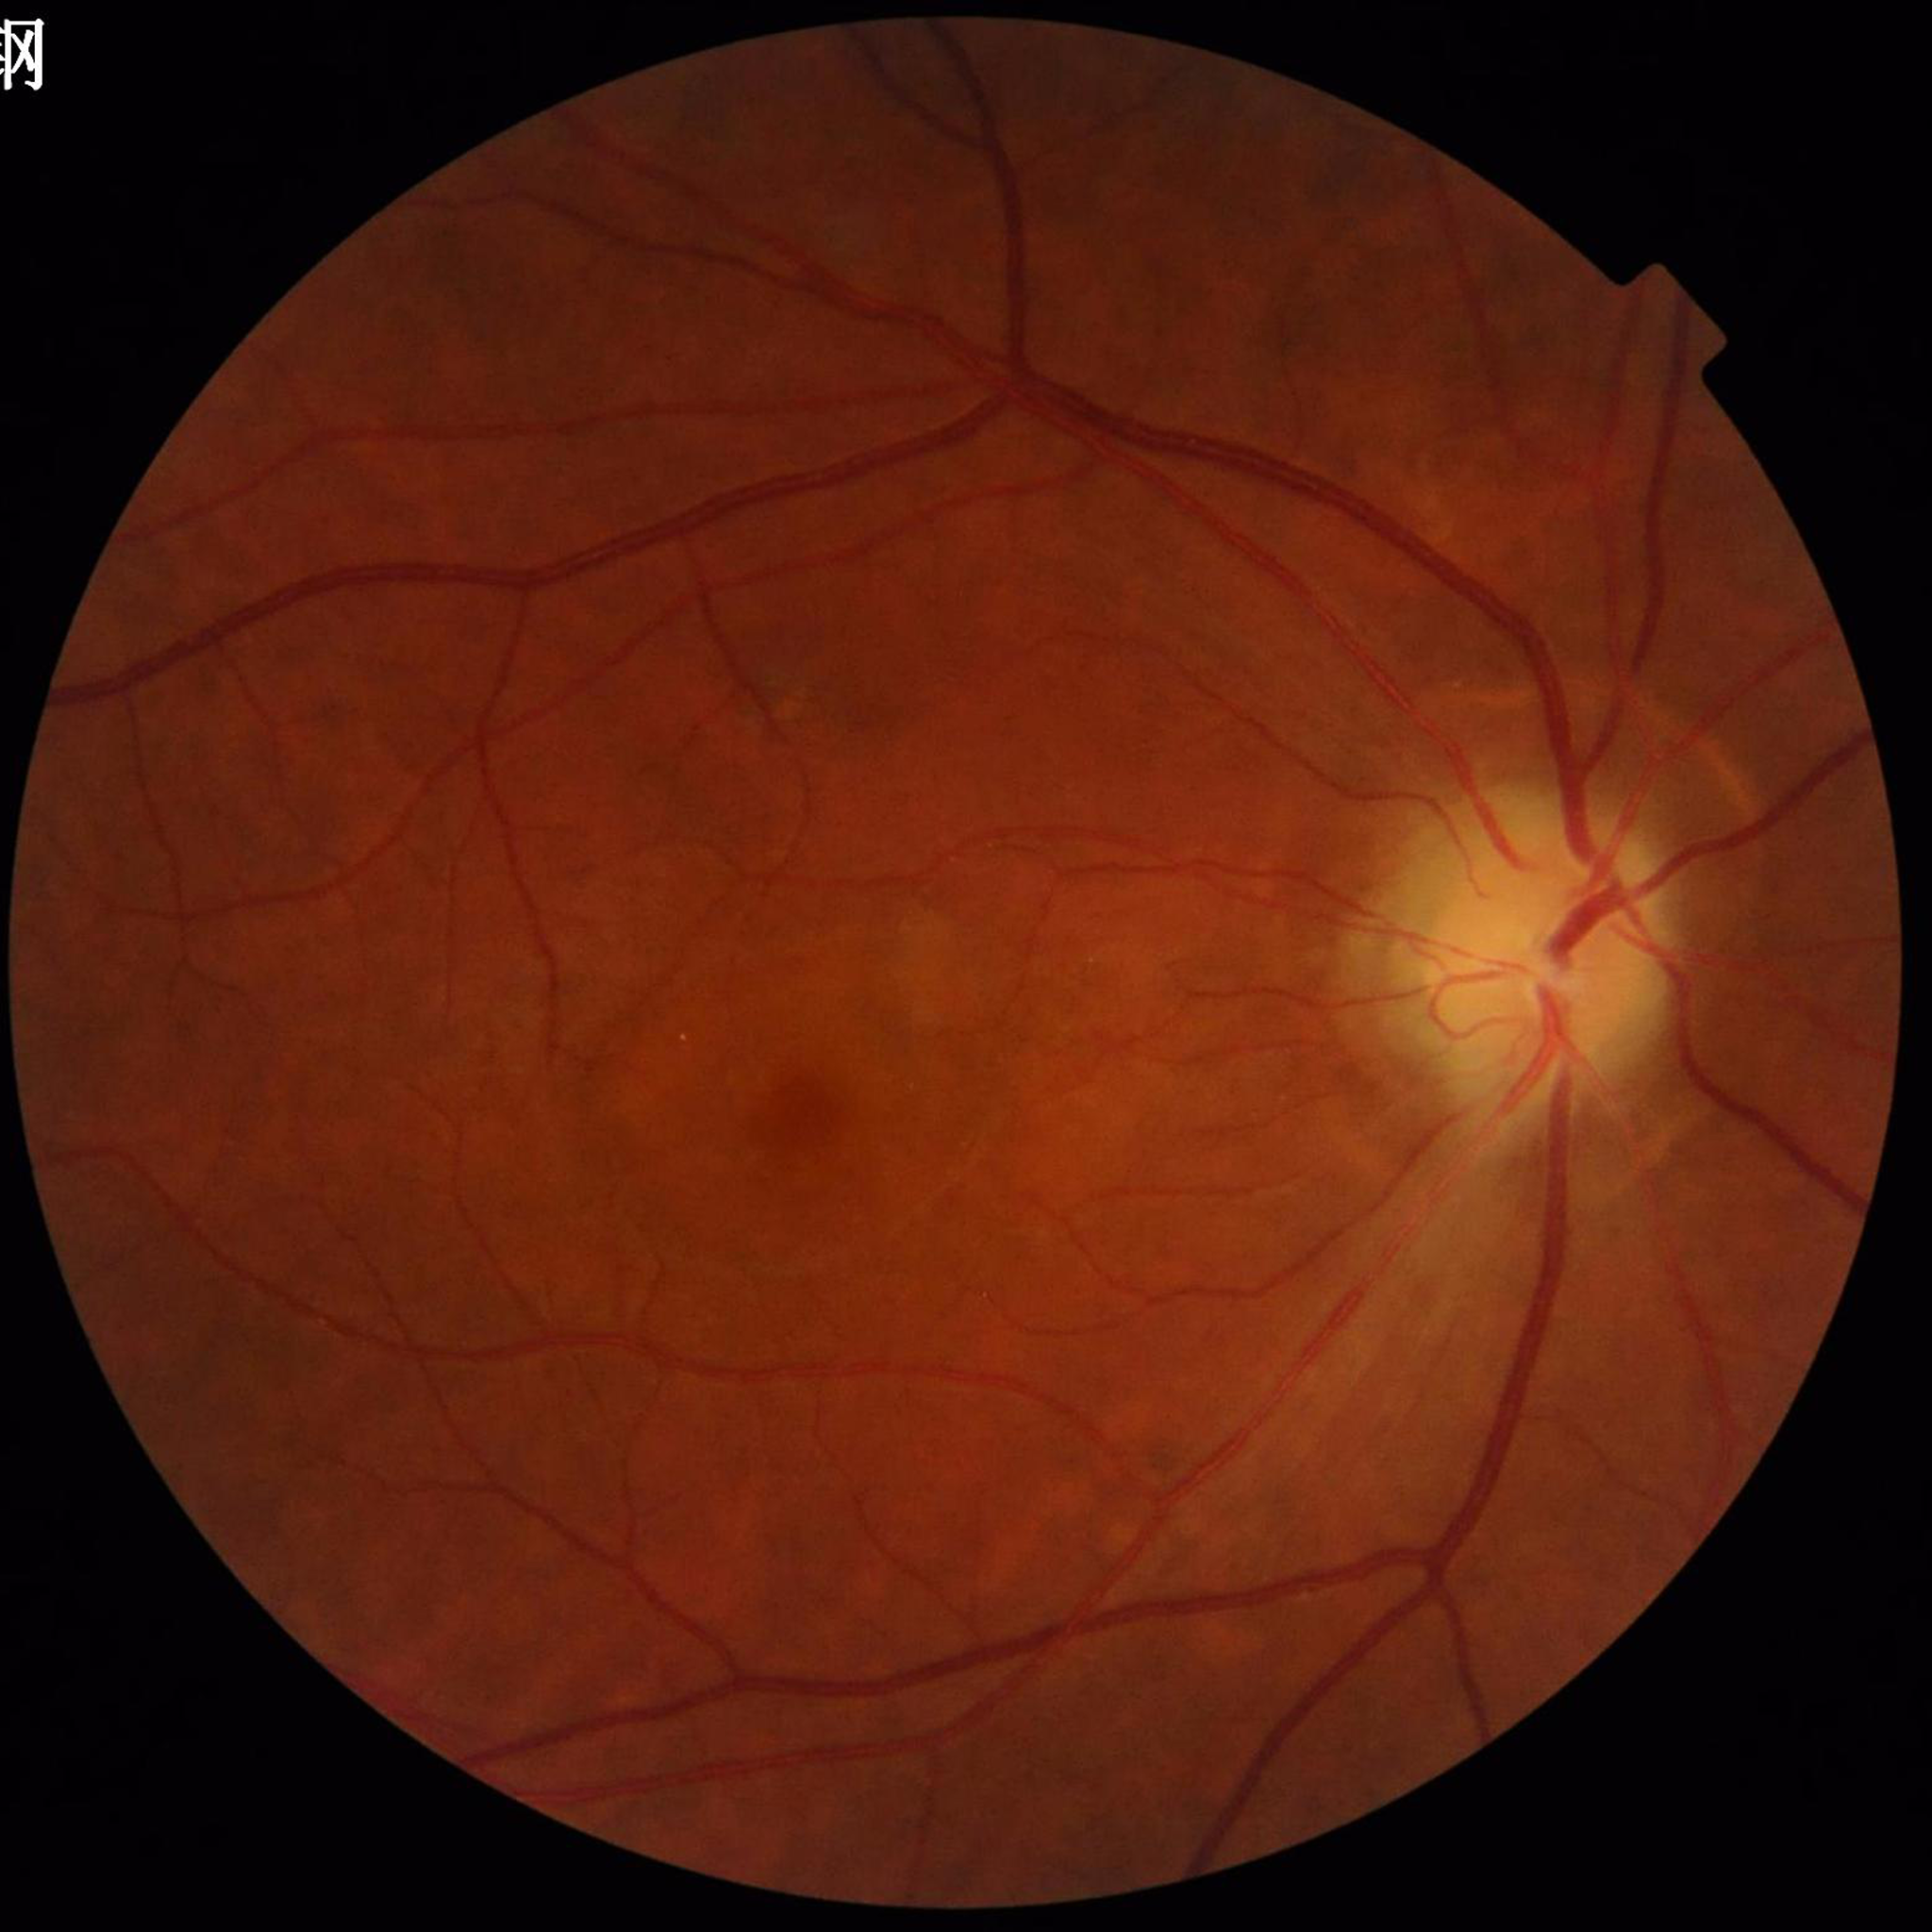 Eye affected by age-related macular degeneration.